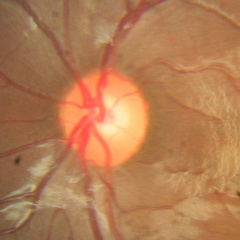

Fundus image with findings of no glaucoma.